45° field of view.
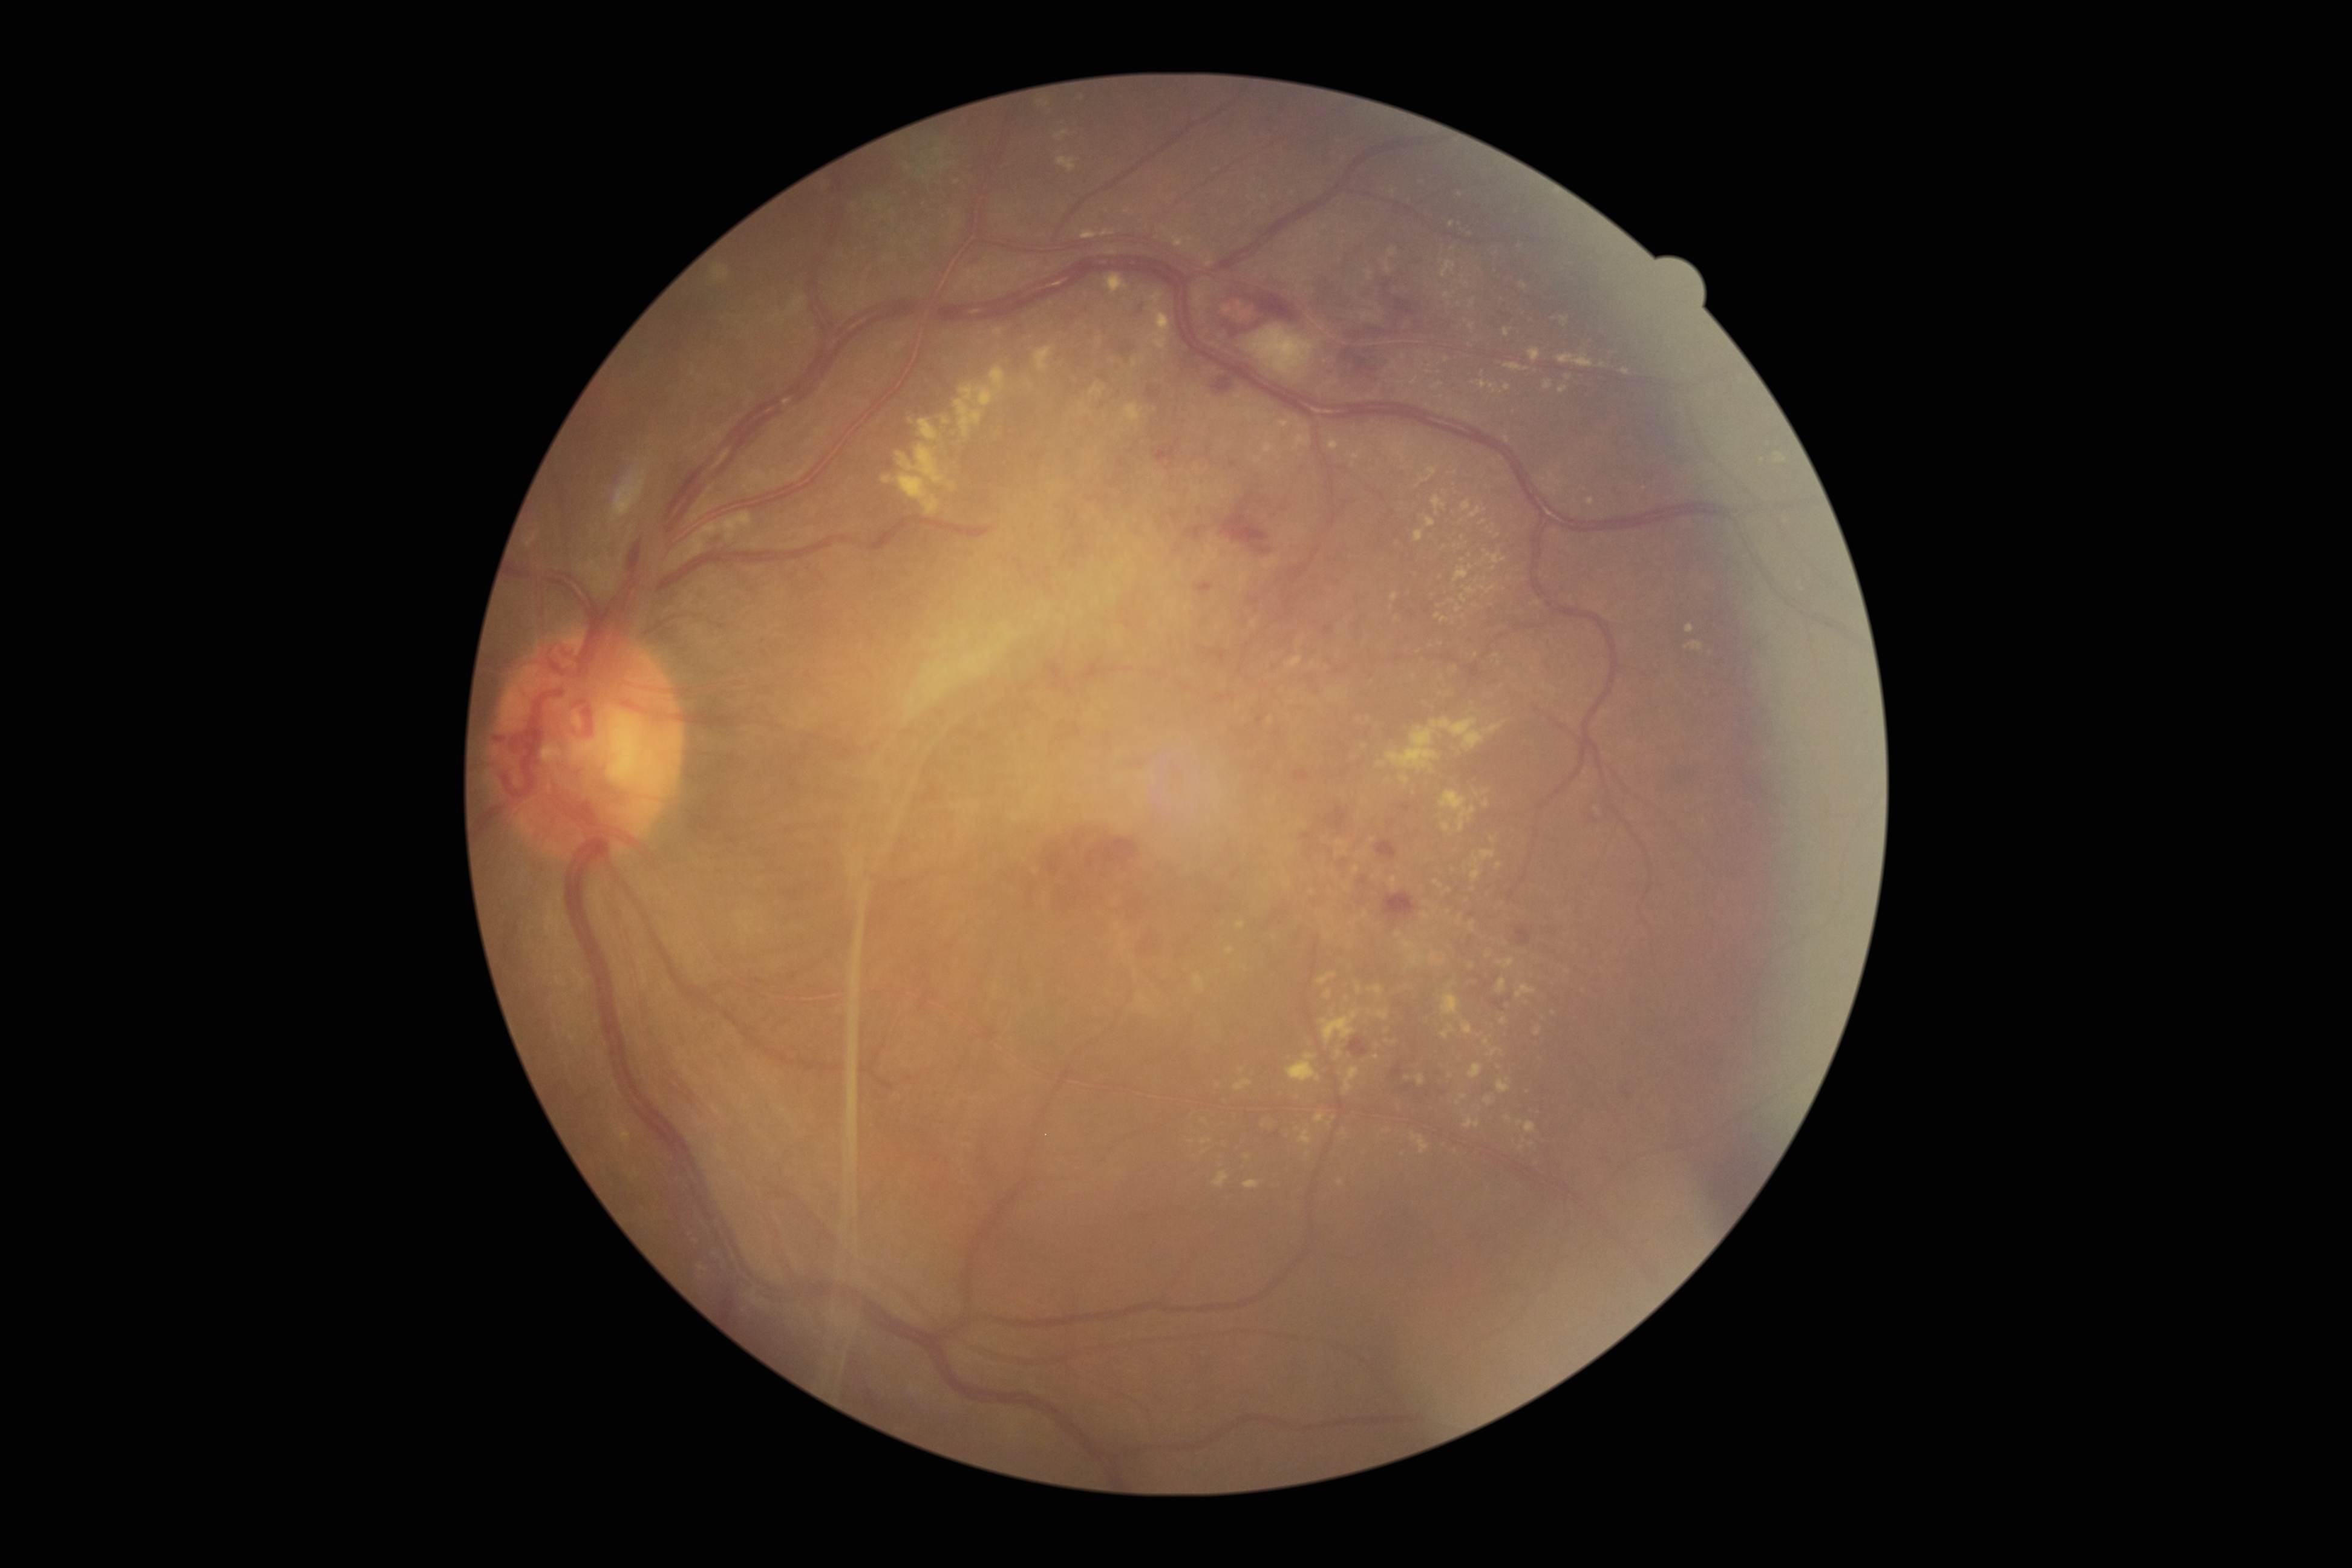 Retinopathy: 4/4
Selected lesions:
hard exudates (subset): <region>1376, 762, 1387, 766</region>, <region>1238, 1067, 1246, 1073</region>, <region>1503, 362, 1530, 371</region>, <region>1433, 879, 1443, 889</region>, <region>1105, 274, 1128, 296</region>, <region>994, 327, 1004, 338</region>, <region>1515, 984, 1537, 999</region>, <region>1279, 420, 1290, 428</region>, <region>1375, 1010, 1391, 1019</region>, <region>1469, 921, 1475, 932</region>, <region>1351, 451, 1363, 466</region>
Hard exudates (small, approximate centers) near Point(1192, 1142), Point(1452, 225), Point(1400, 383), Point(1329, 1124), Point(1520, 1123), Point(1450, 1076), Point(1499, 865), Point(1388, 1130)